Phoenix ICON wide-field infant fundus image; camera: Phoenix ICON (100° FOV)
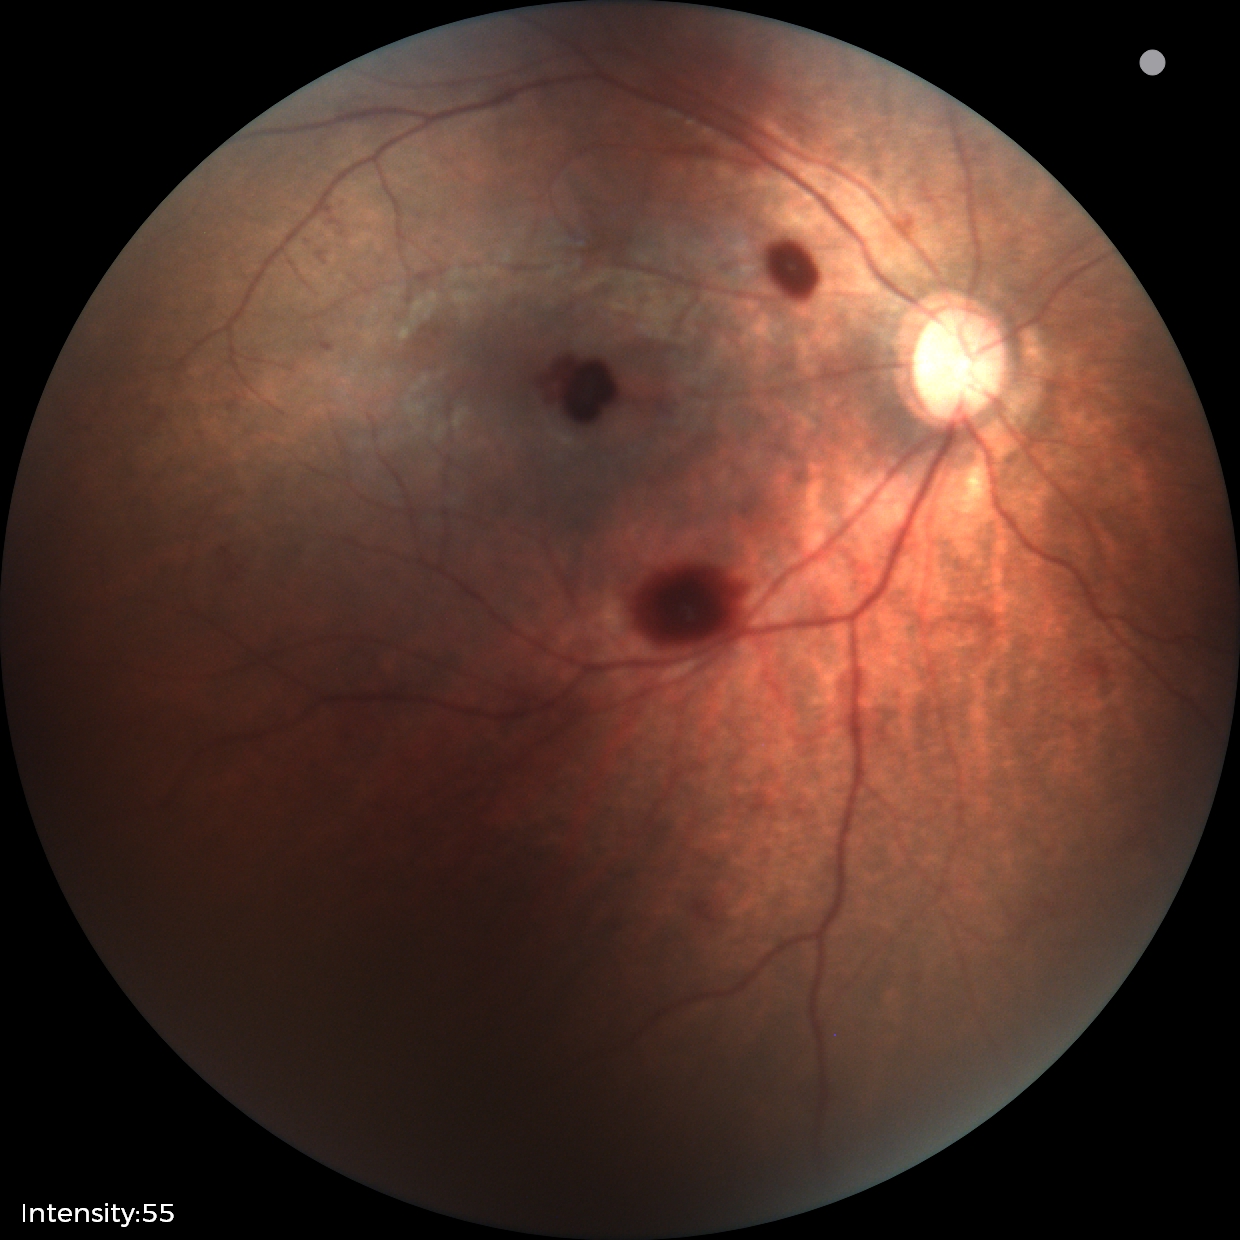
Impression: retinal hemorrhages.